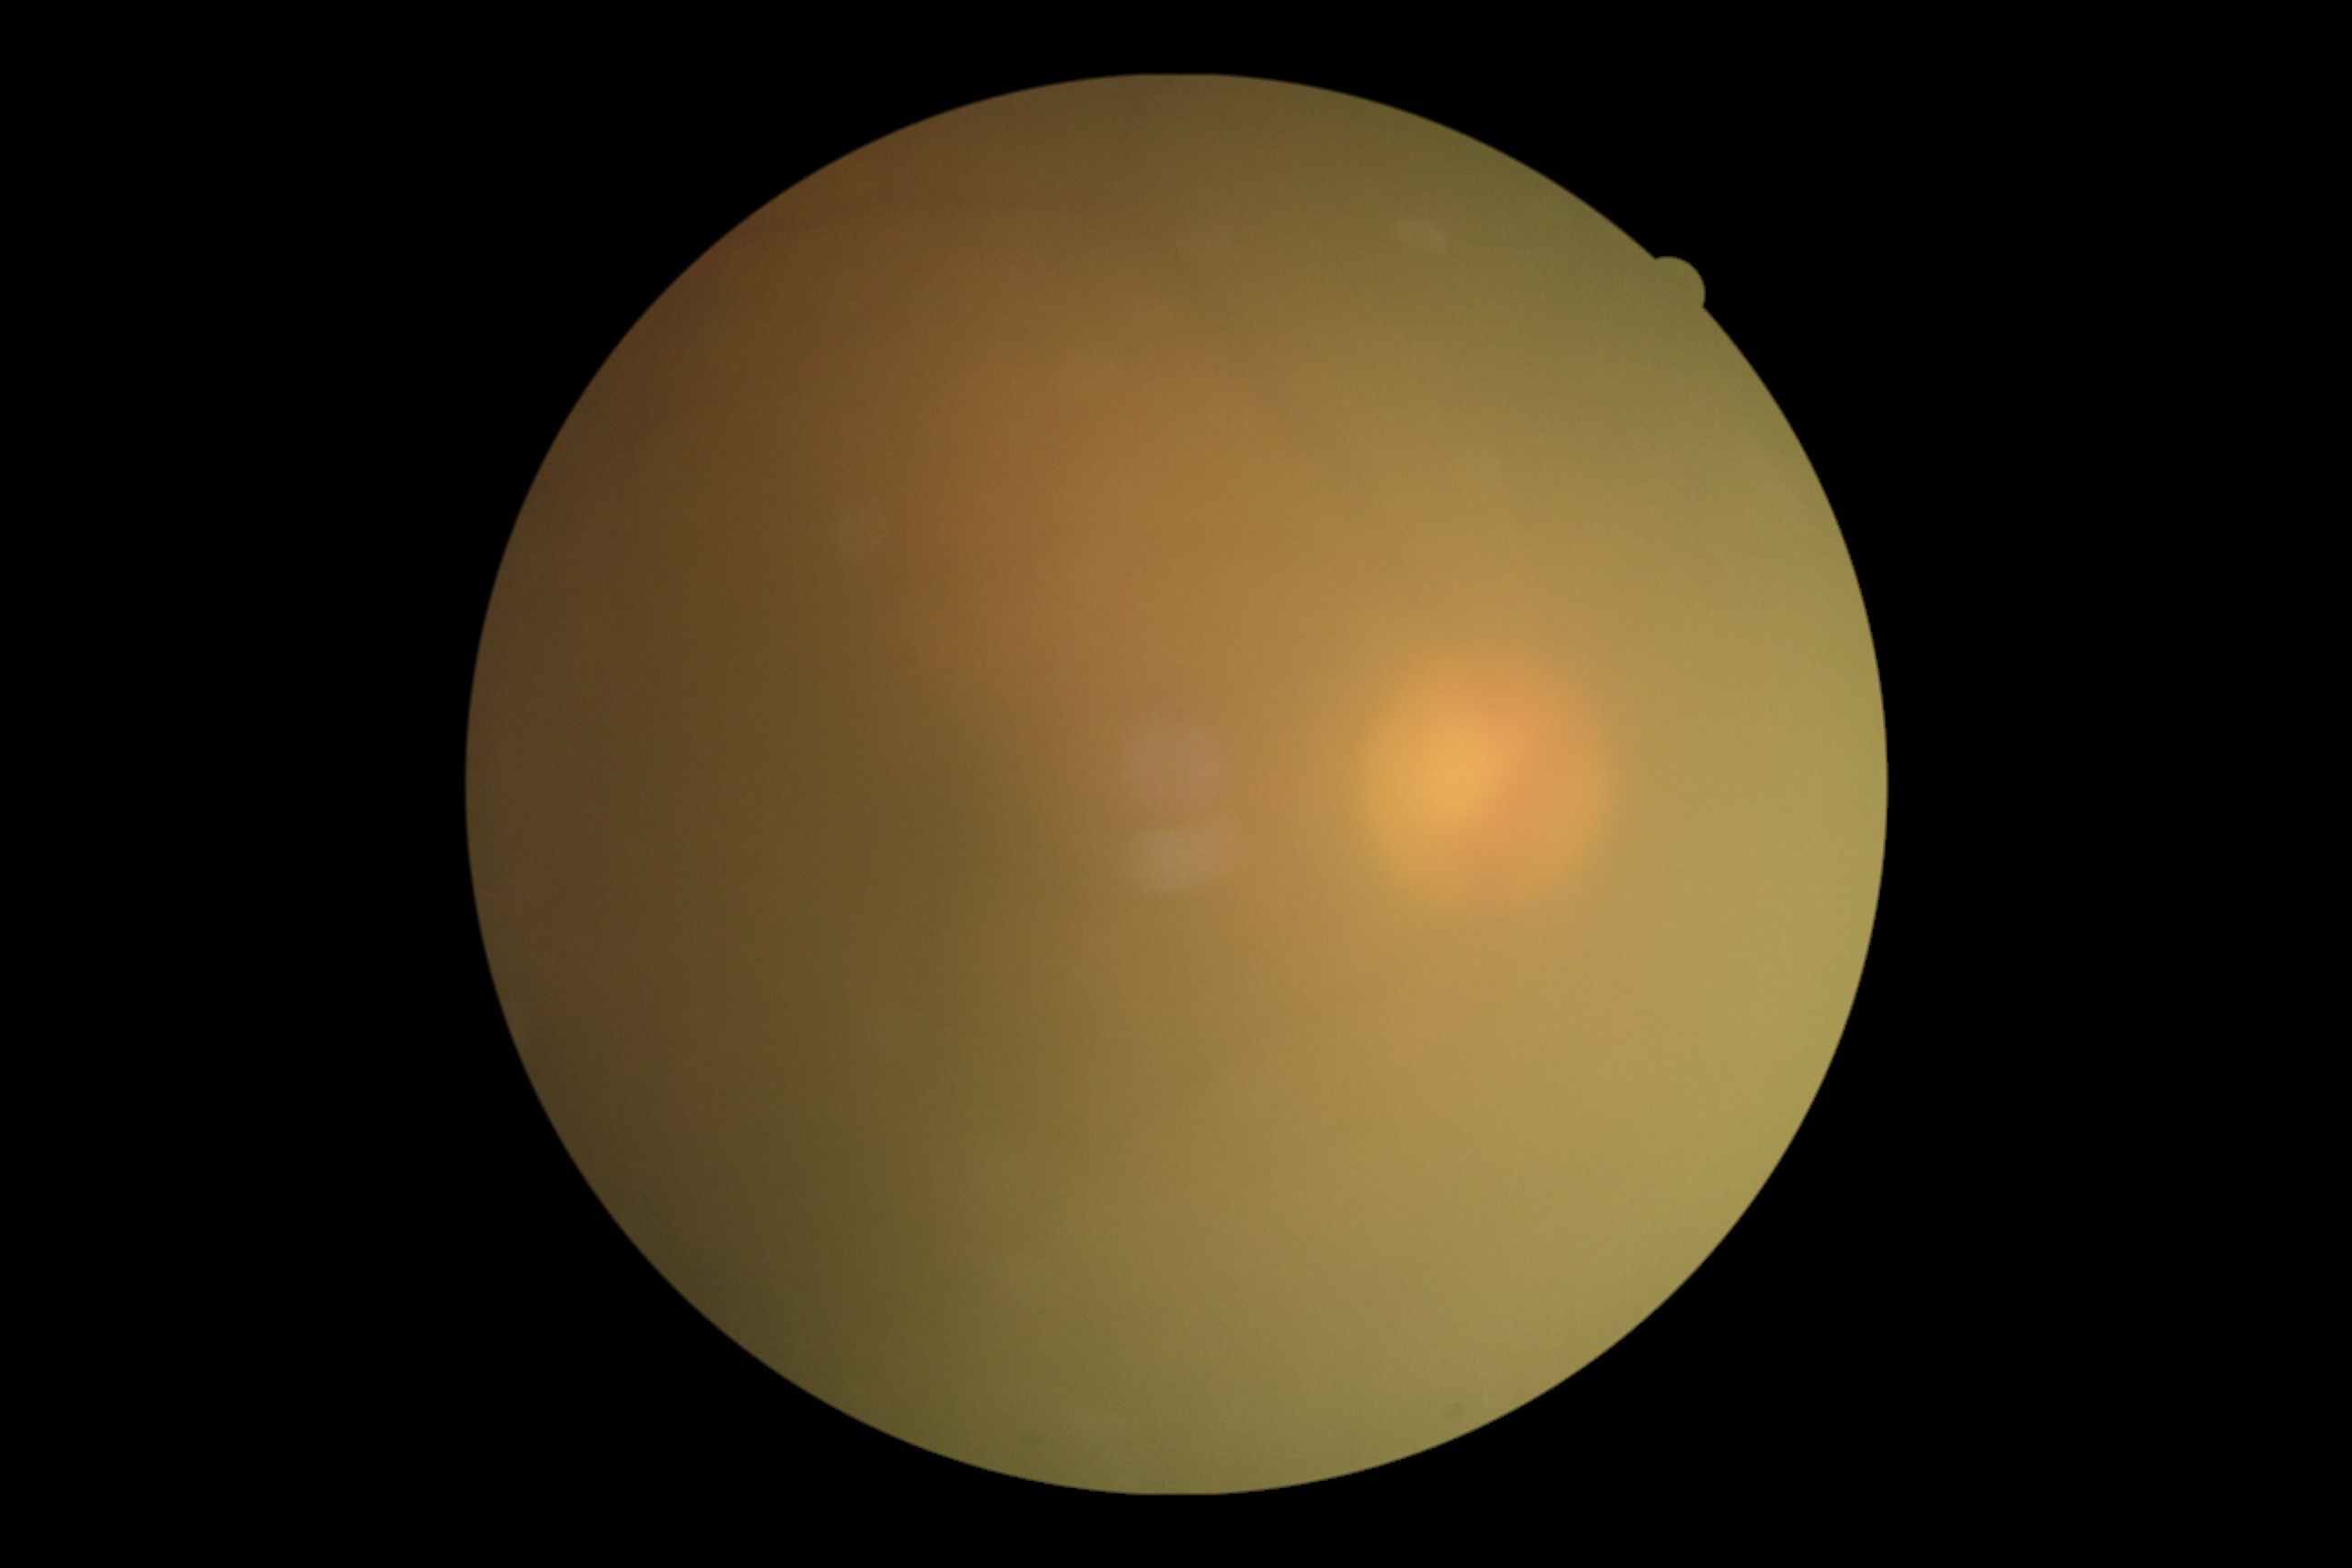 Annotations:
• diabetic retinopathy grade — ungradable due to poor image quality